45° FOV — 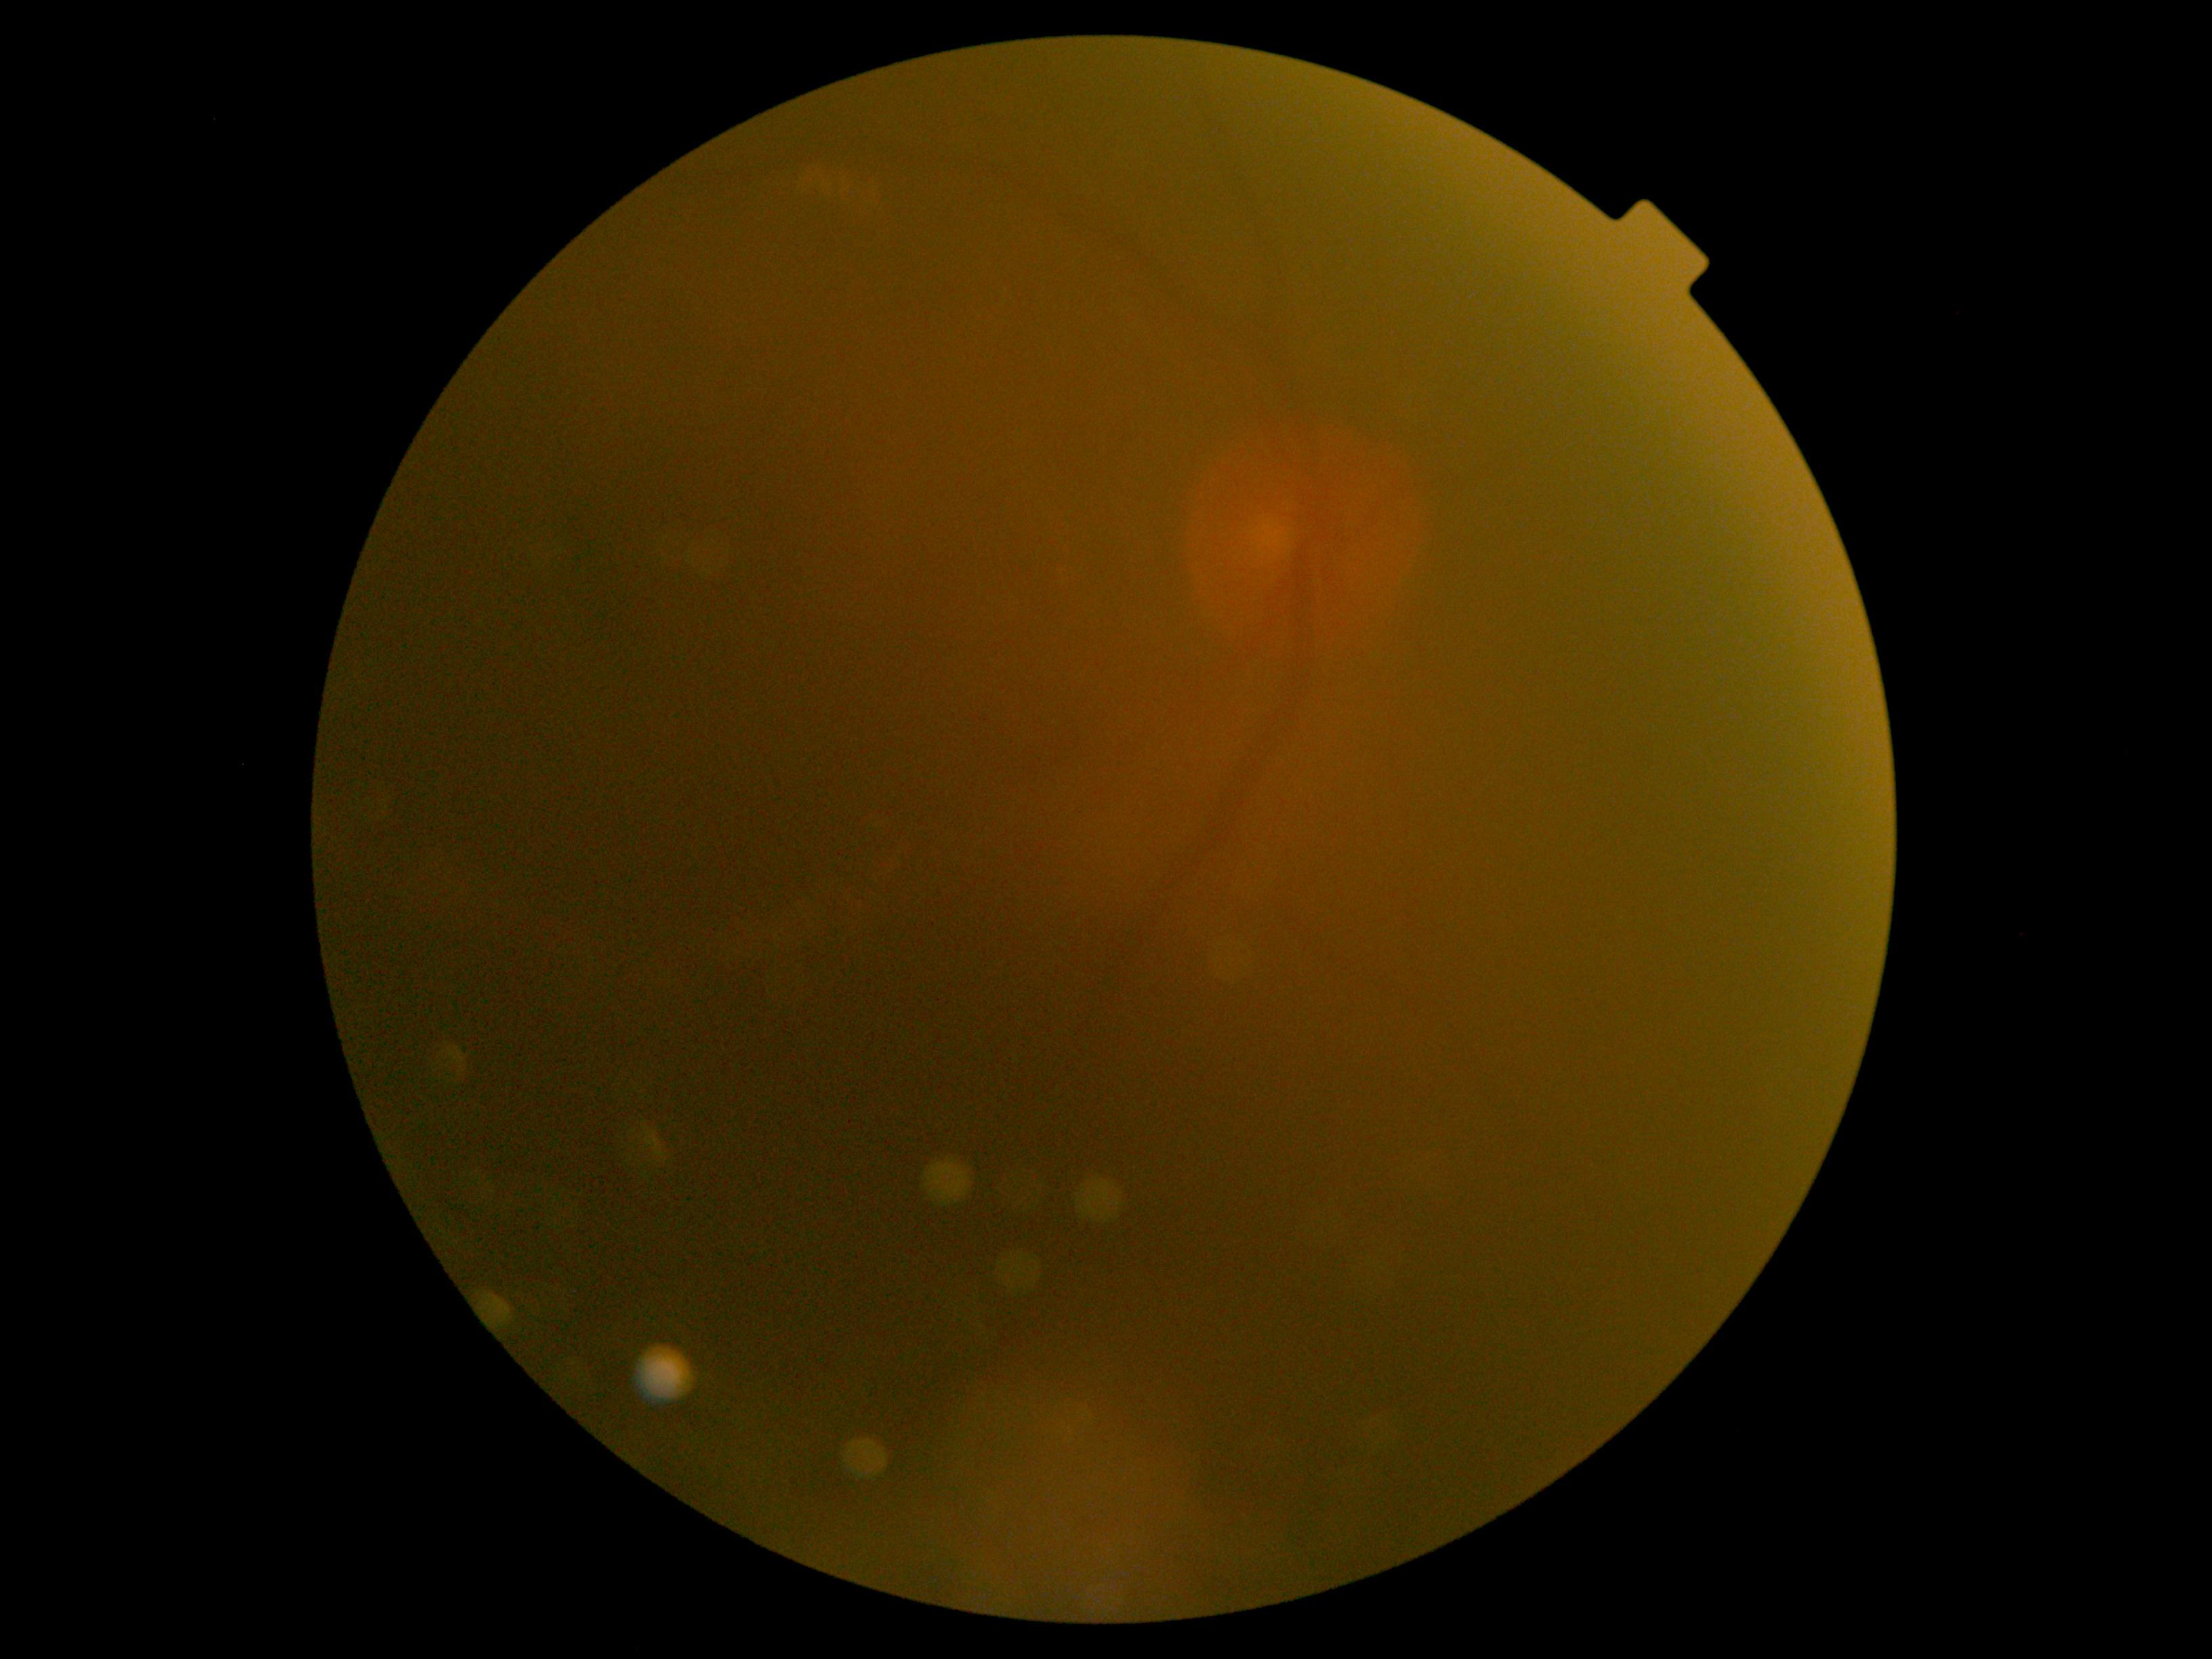
DR grade = ungradable due to poor image quality; image quality = insufficient.